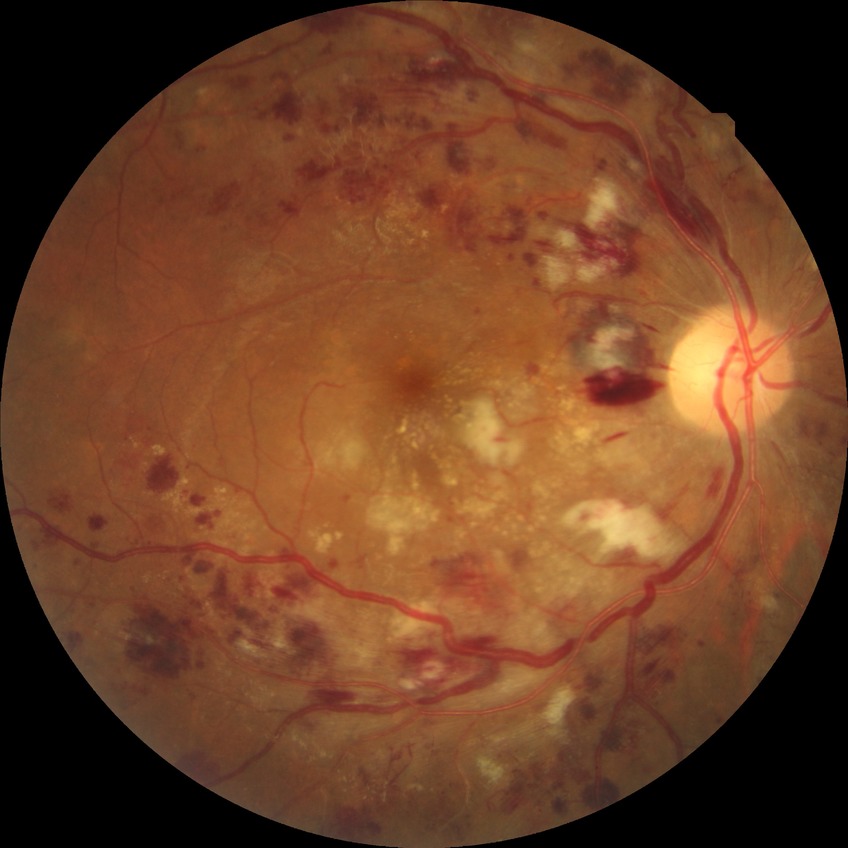 Findings:
* DR class — non-proliferative diabetic retinopathy
* diabetic retinopathy (DR) — pre-proliferative diabetic retinopathy (PPDR)